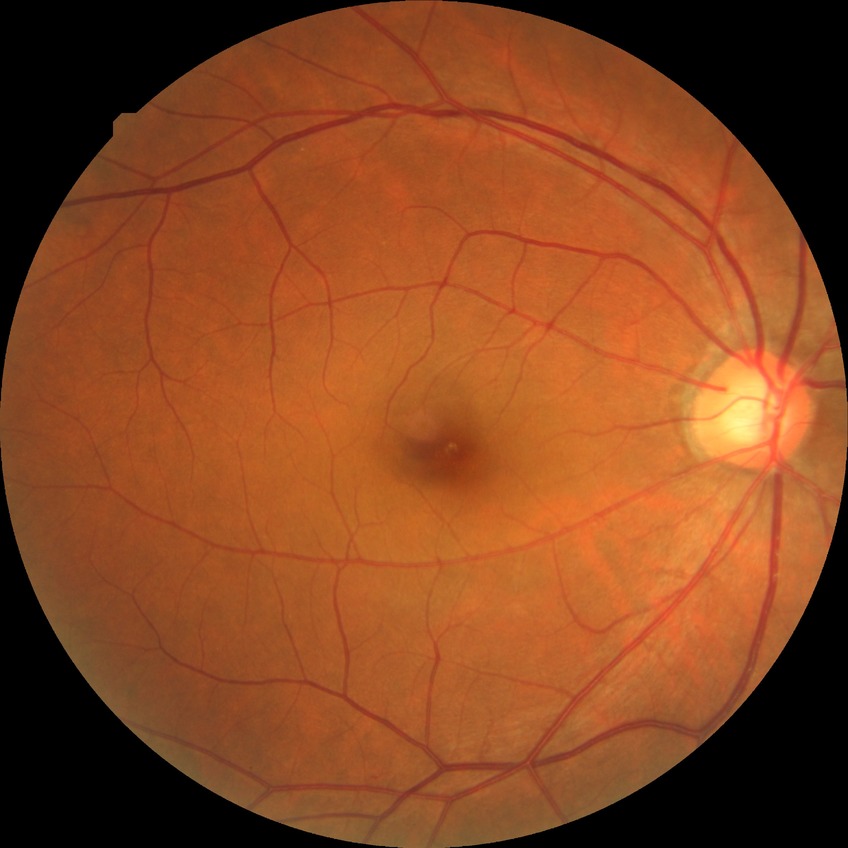 Diabetic retinopathy severity is no diabetic retinopathy.